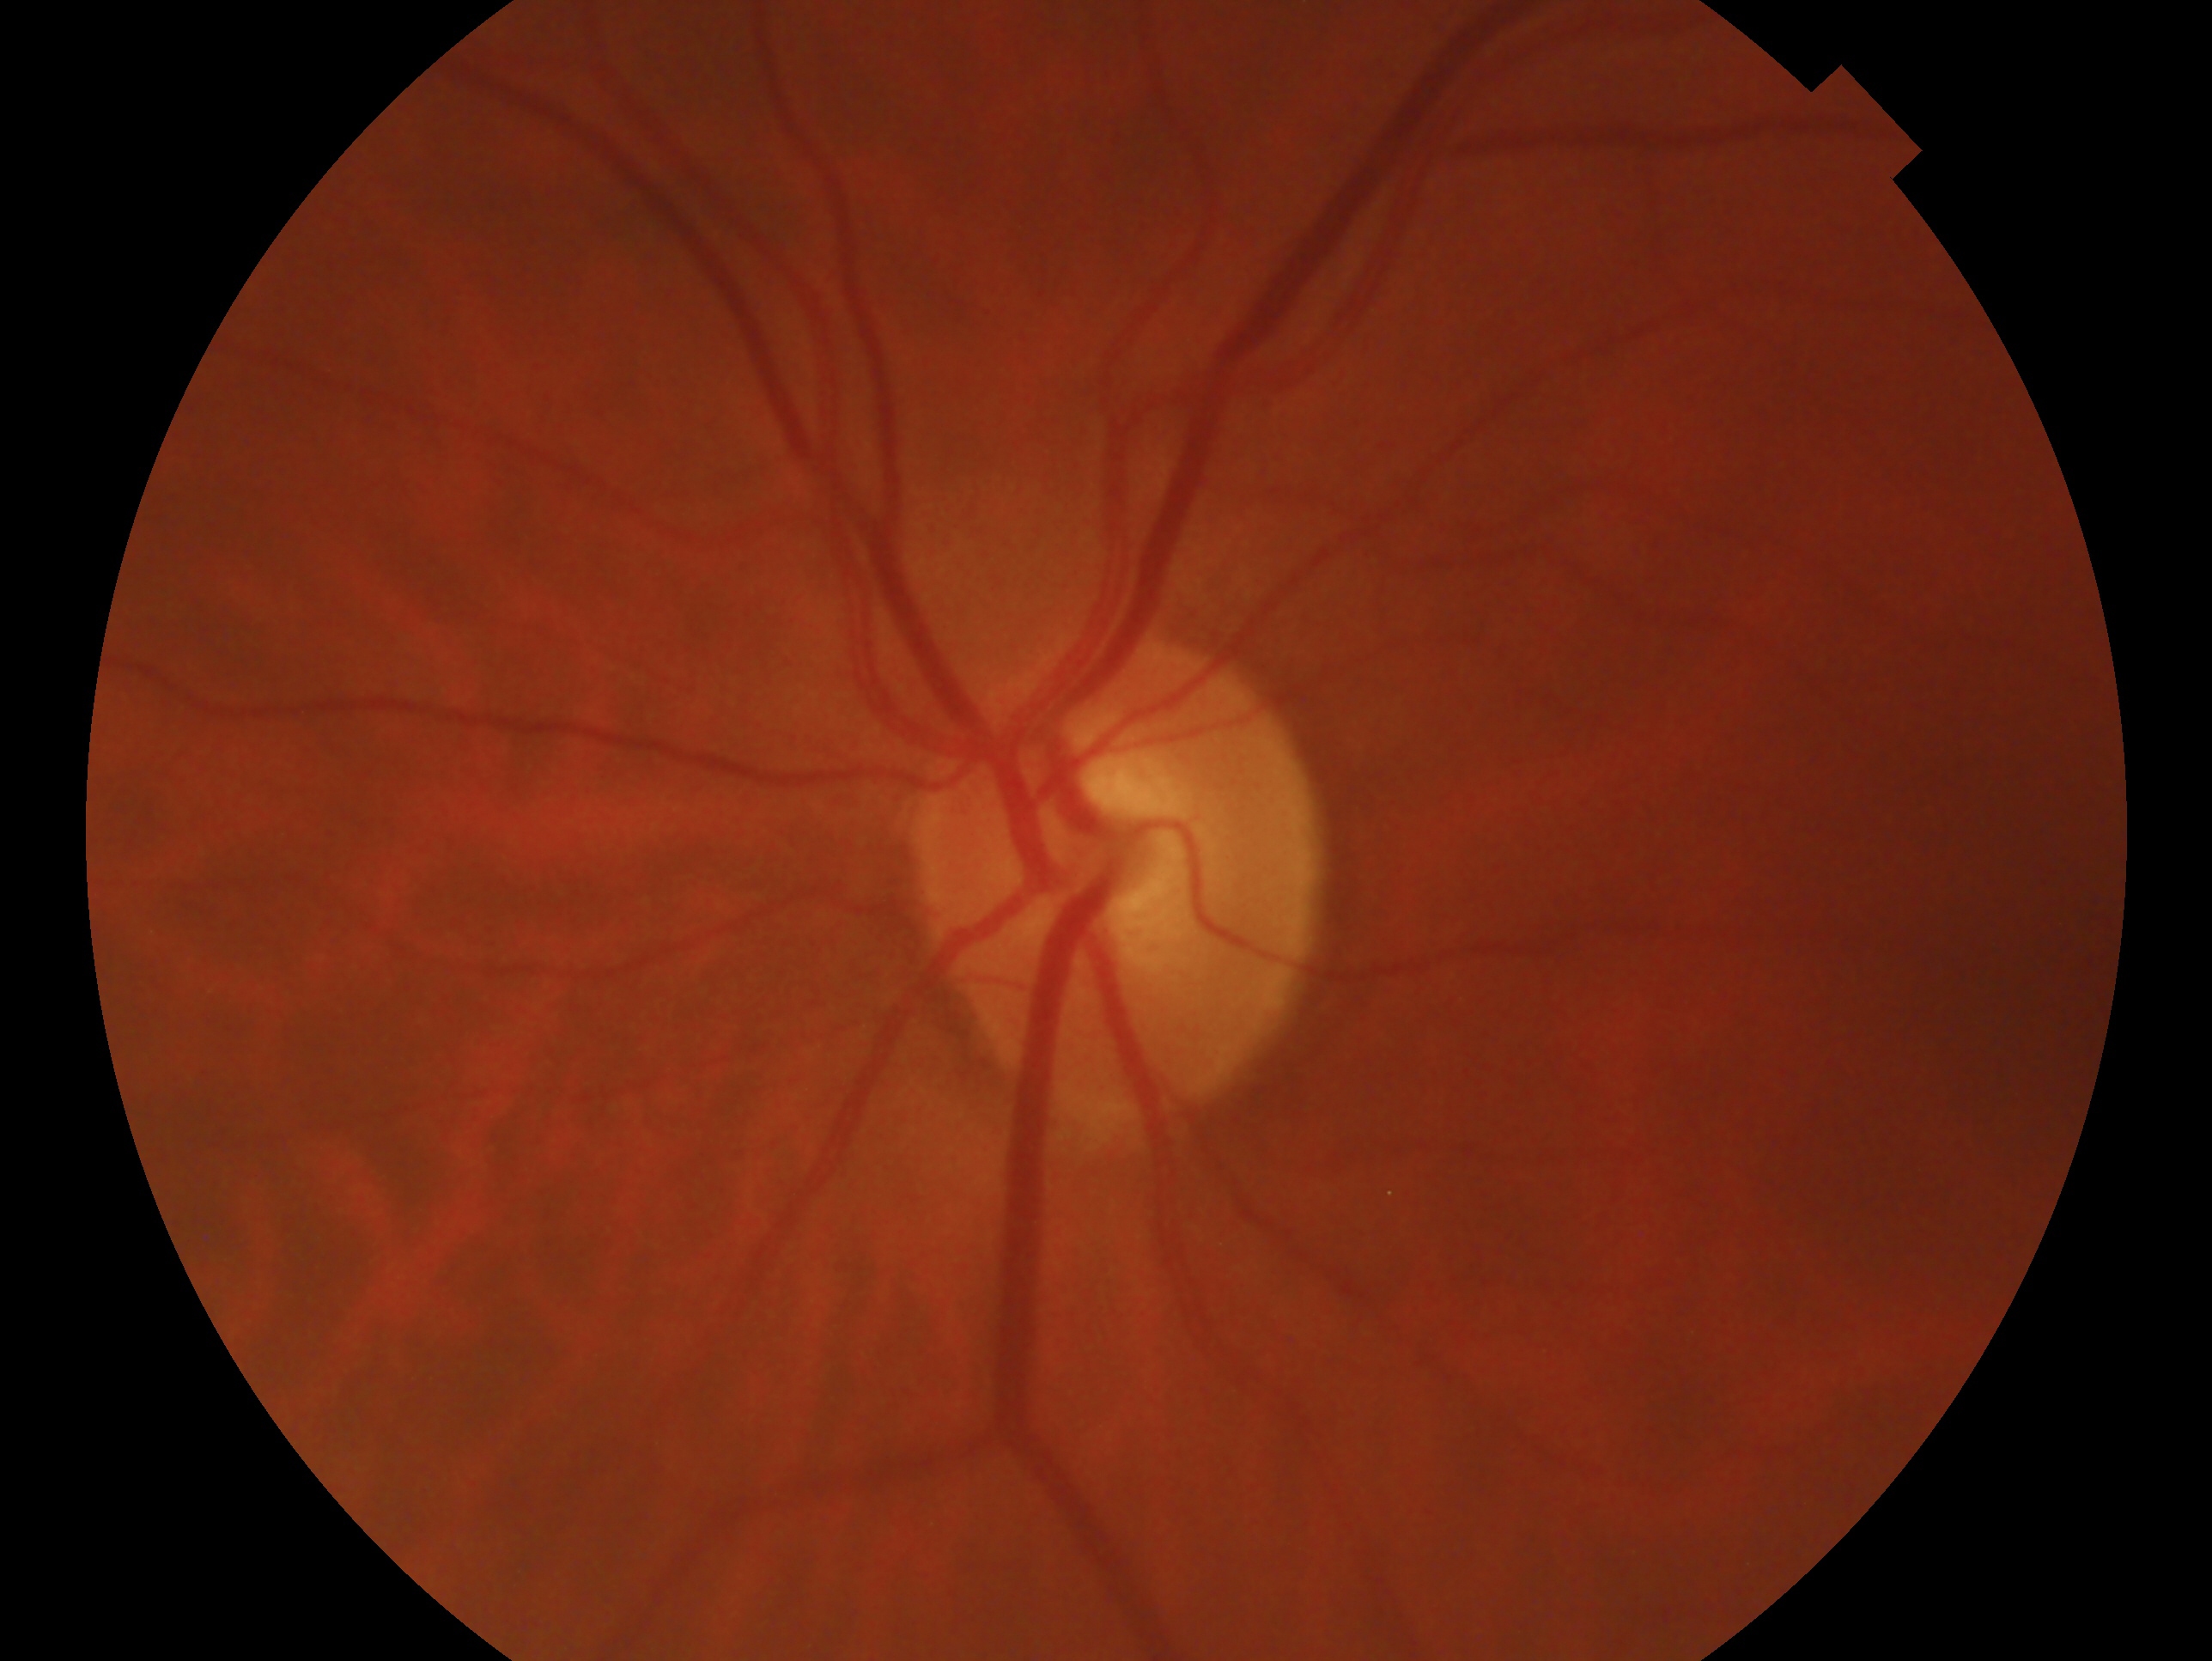 glaucoma assessment: no signs of glaucoma, eye: OS.